Intraocular pressure (IOP) 19 mmHg by non-contact tonometry; optic disc at the center of the field; age 53; sex: M:
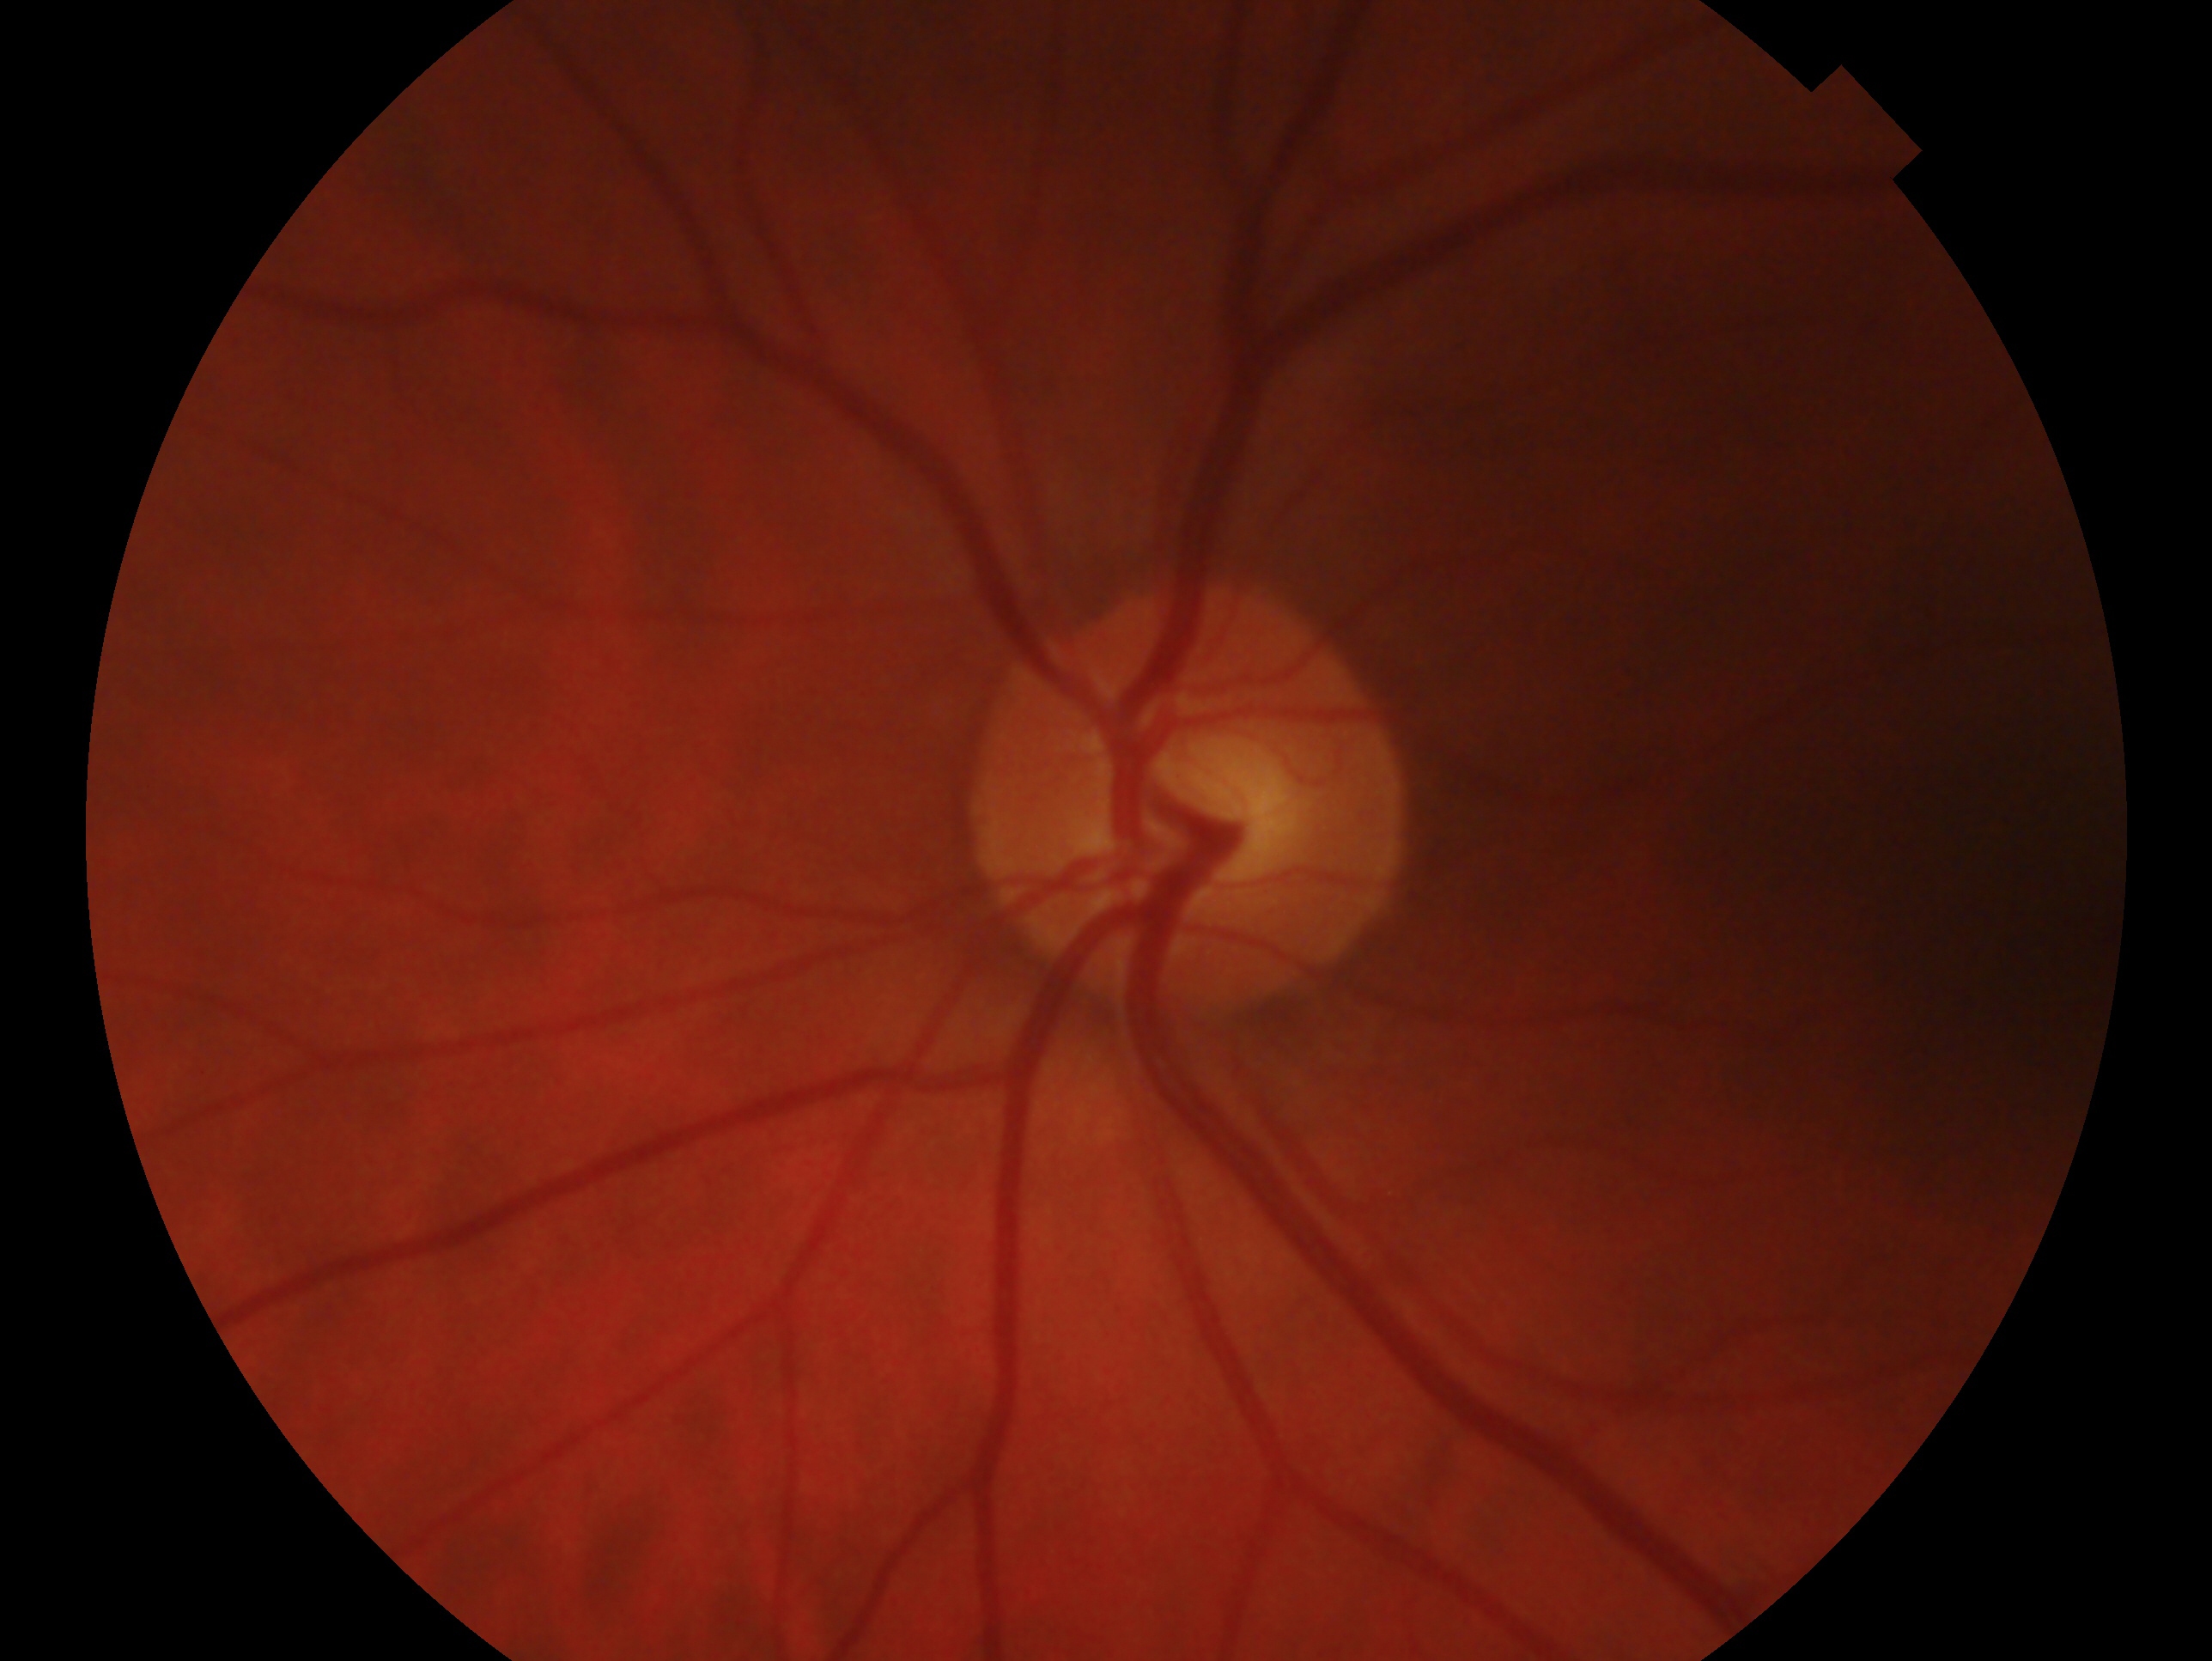 Q: Glaucoma classification?
A: negative for glaucoma
Q: Right or left eye?
A: left eye